45° field of view · CFP · 1536 by 1152 pixels: 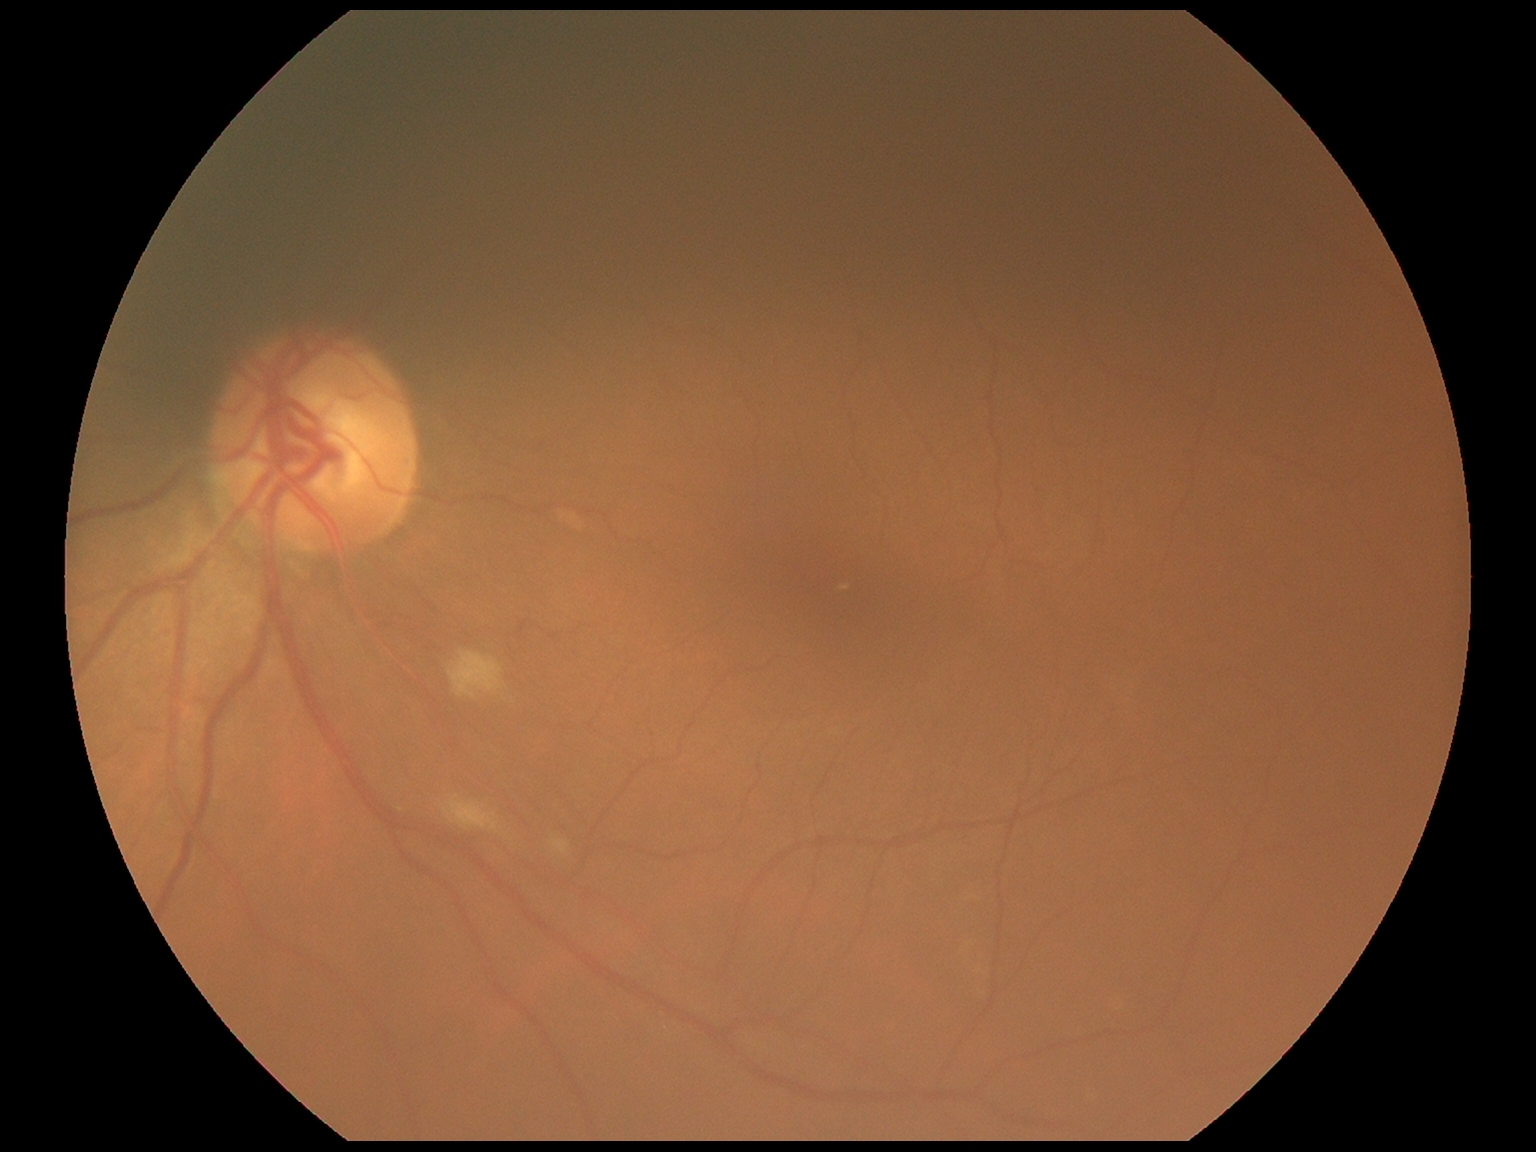 retinopathy: 2/4; DR class: non-proliferative diabetic retinopathy.